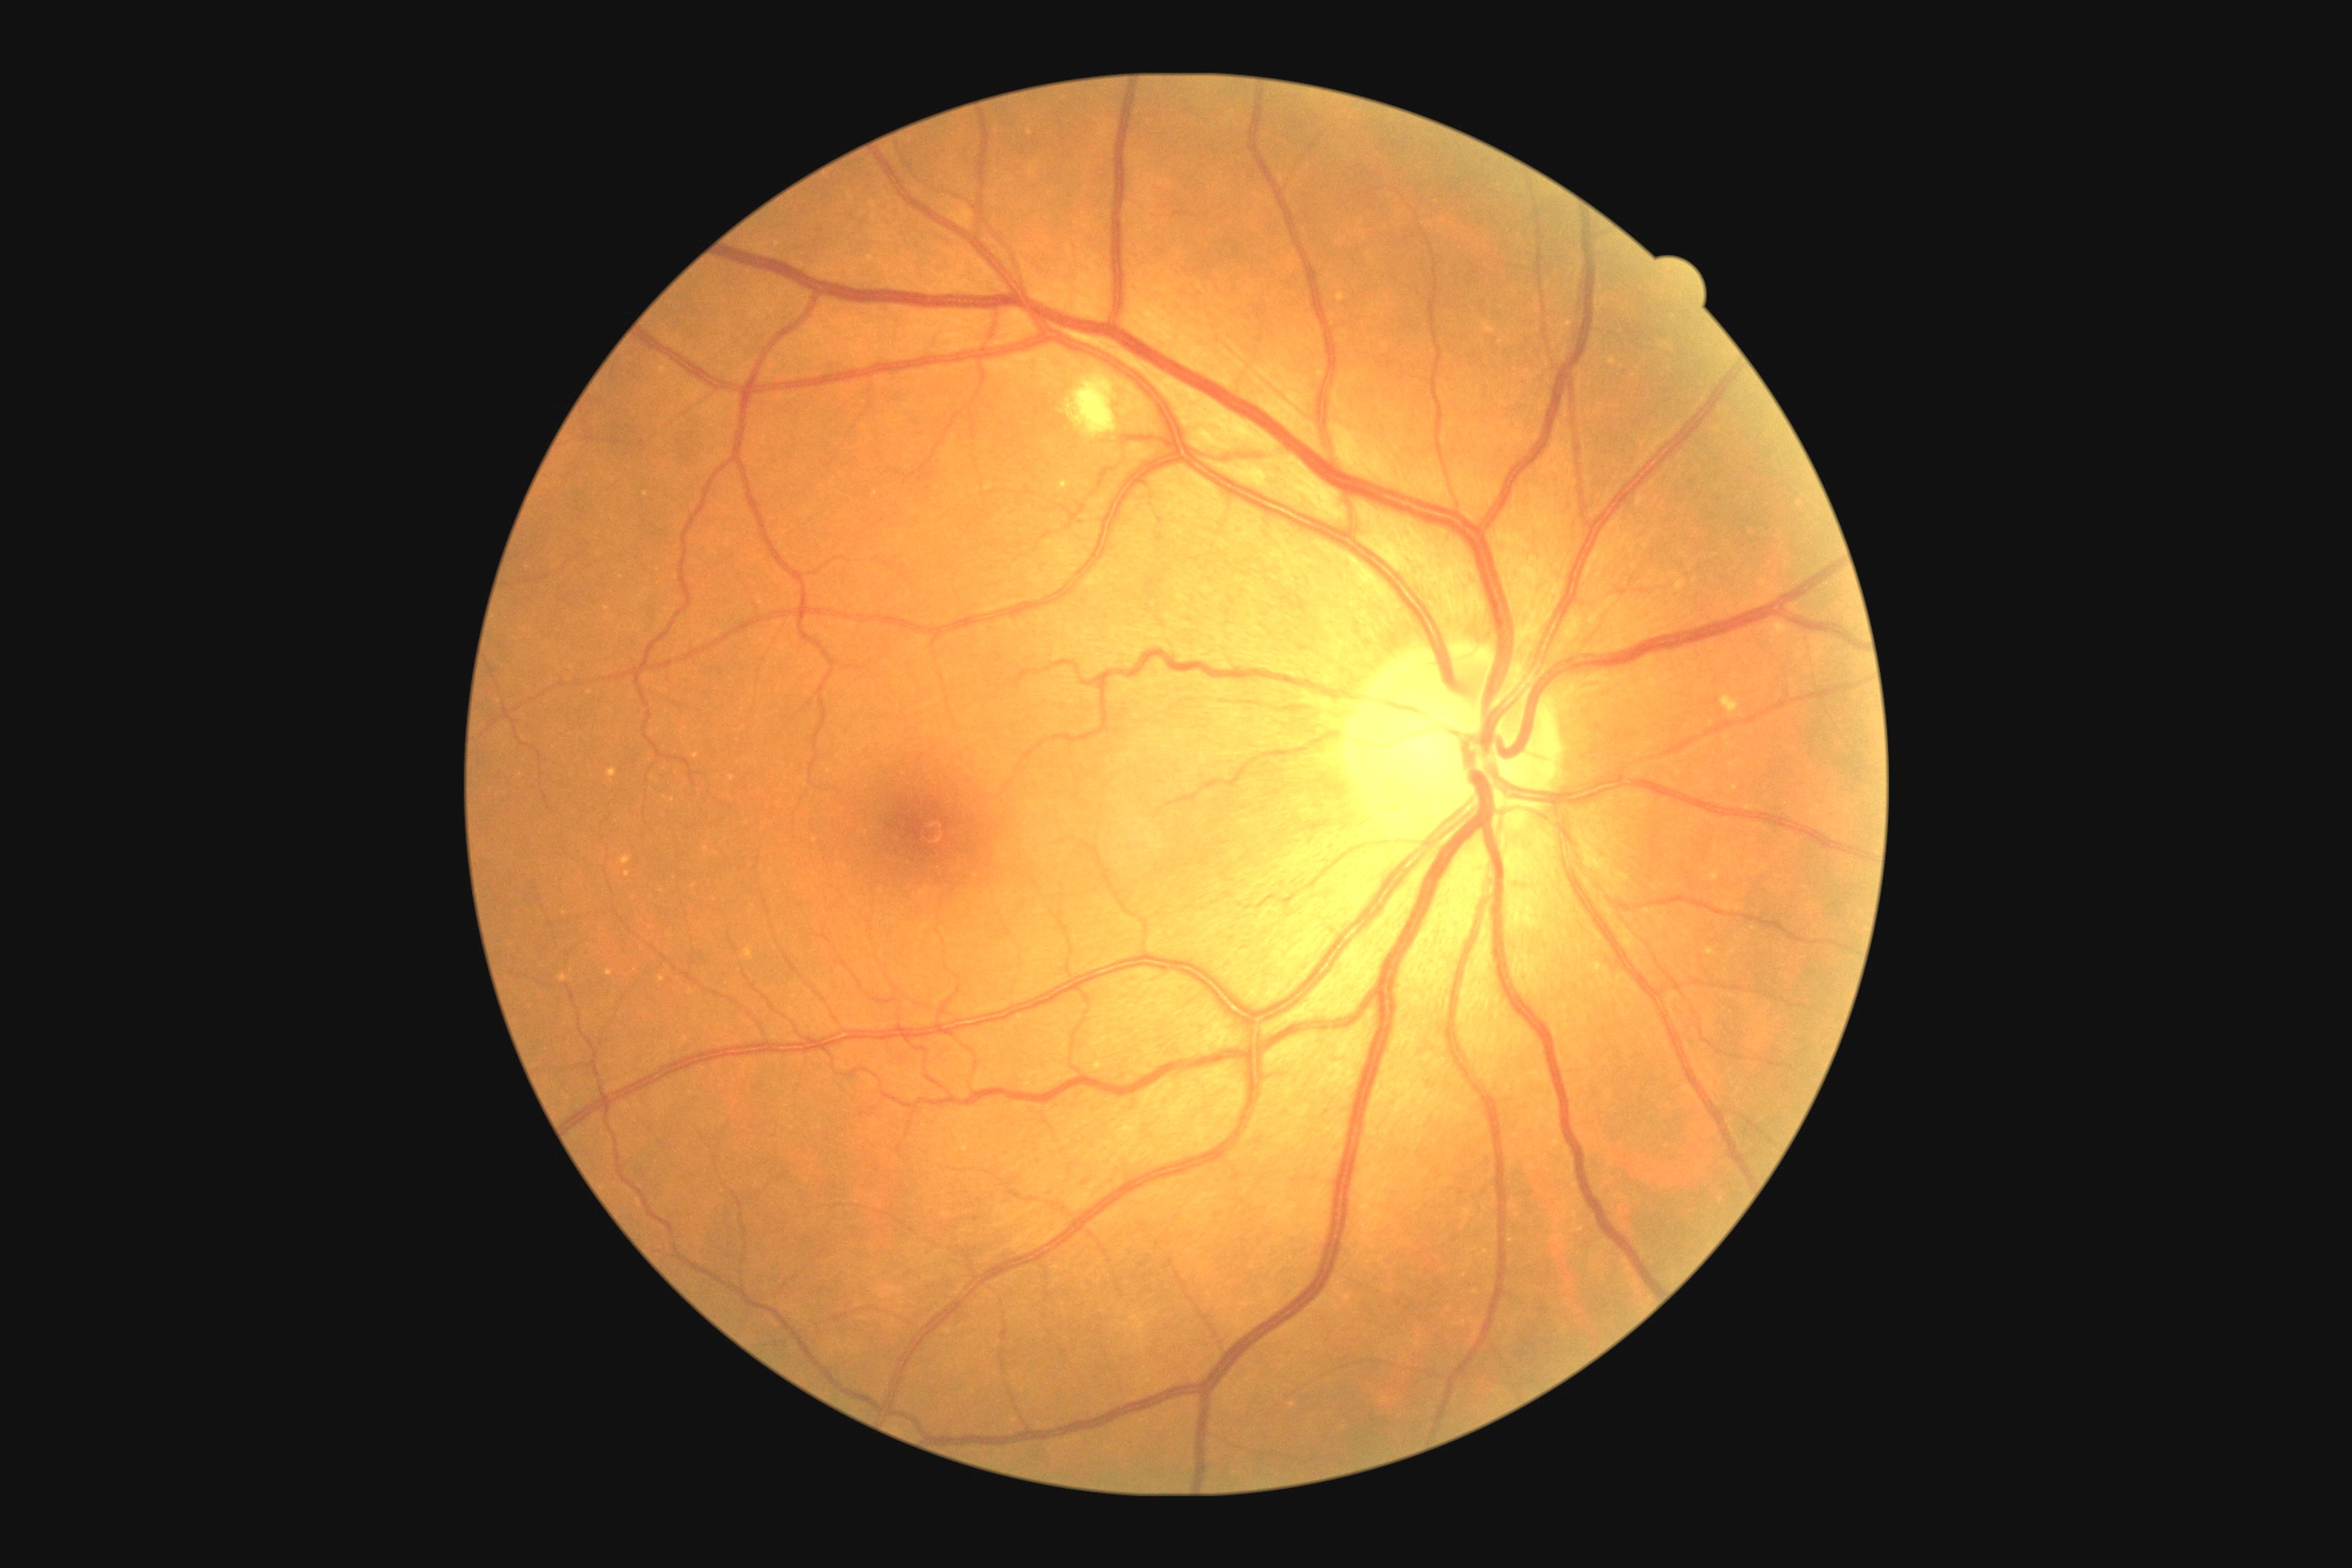
DR is 2.